Wide-field fundus photograph of an infant — 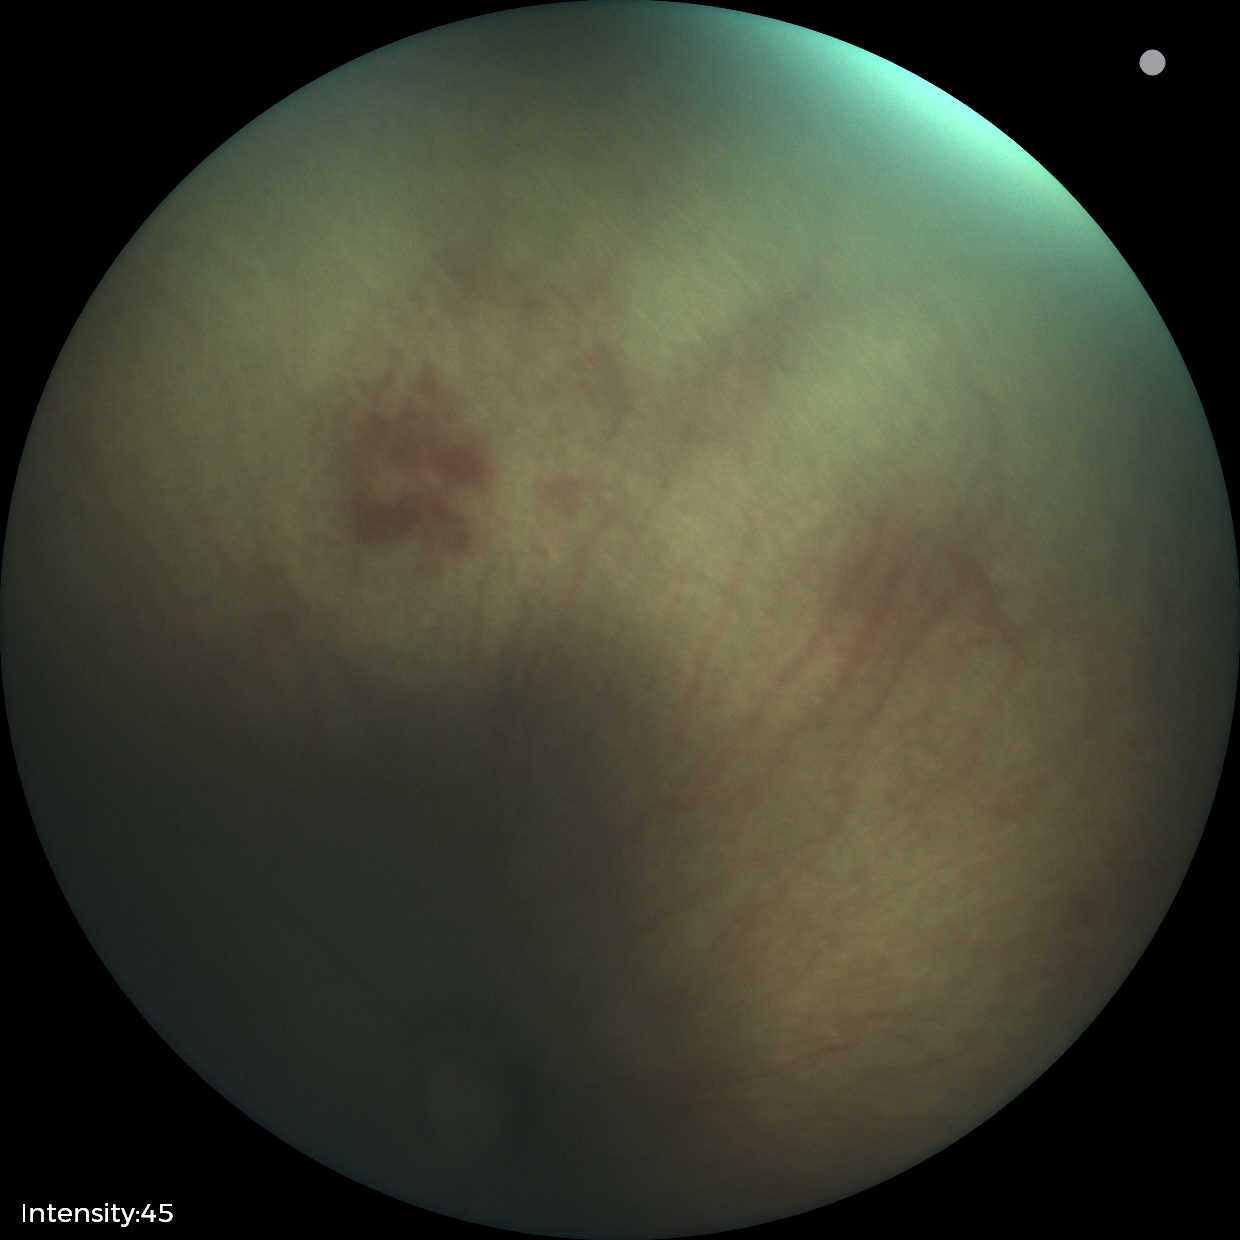 Screening series with ROP stage 0.
Plus disease absent.